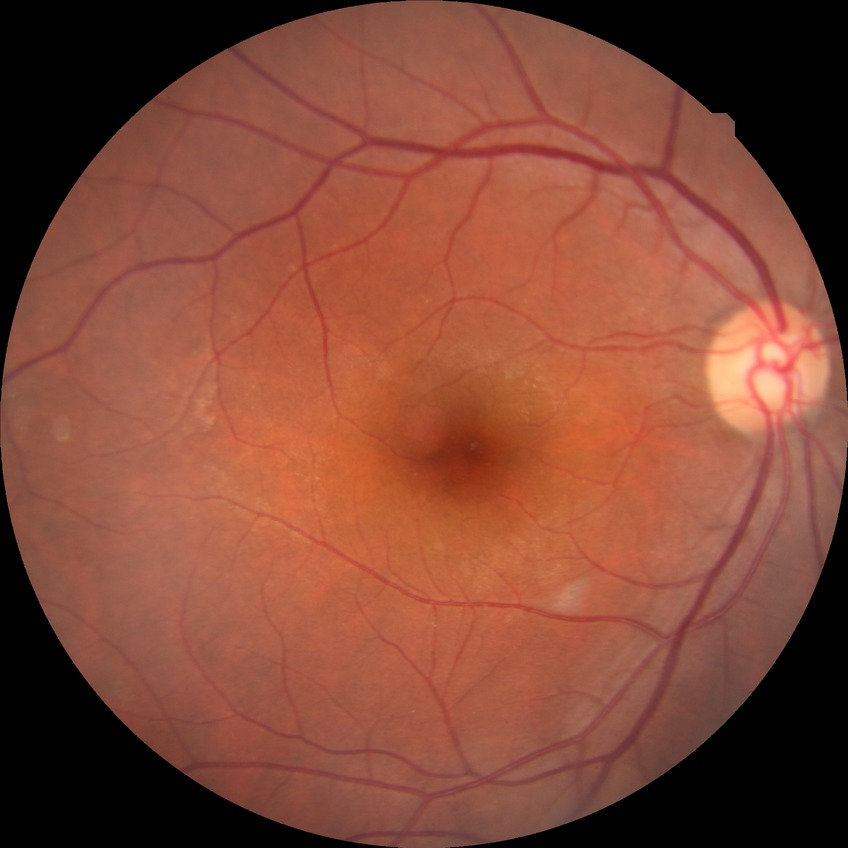

* Davis grade — NDR